FOV: 45 degrees
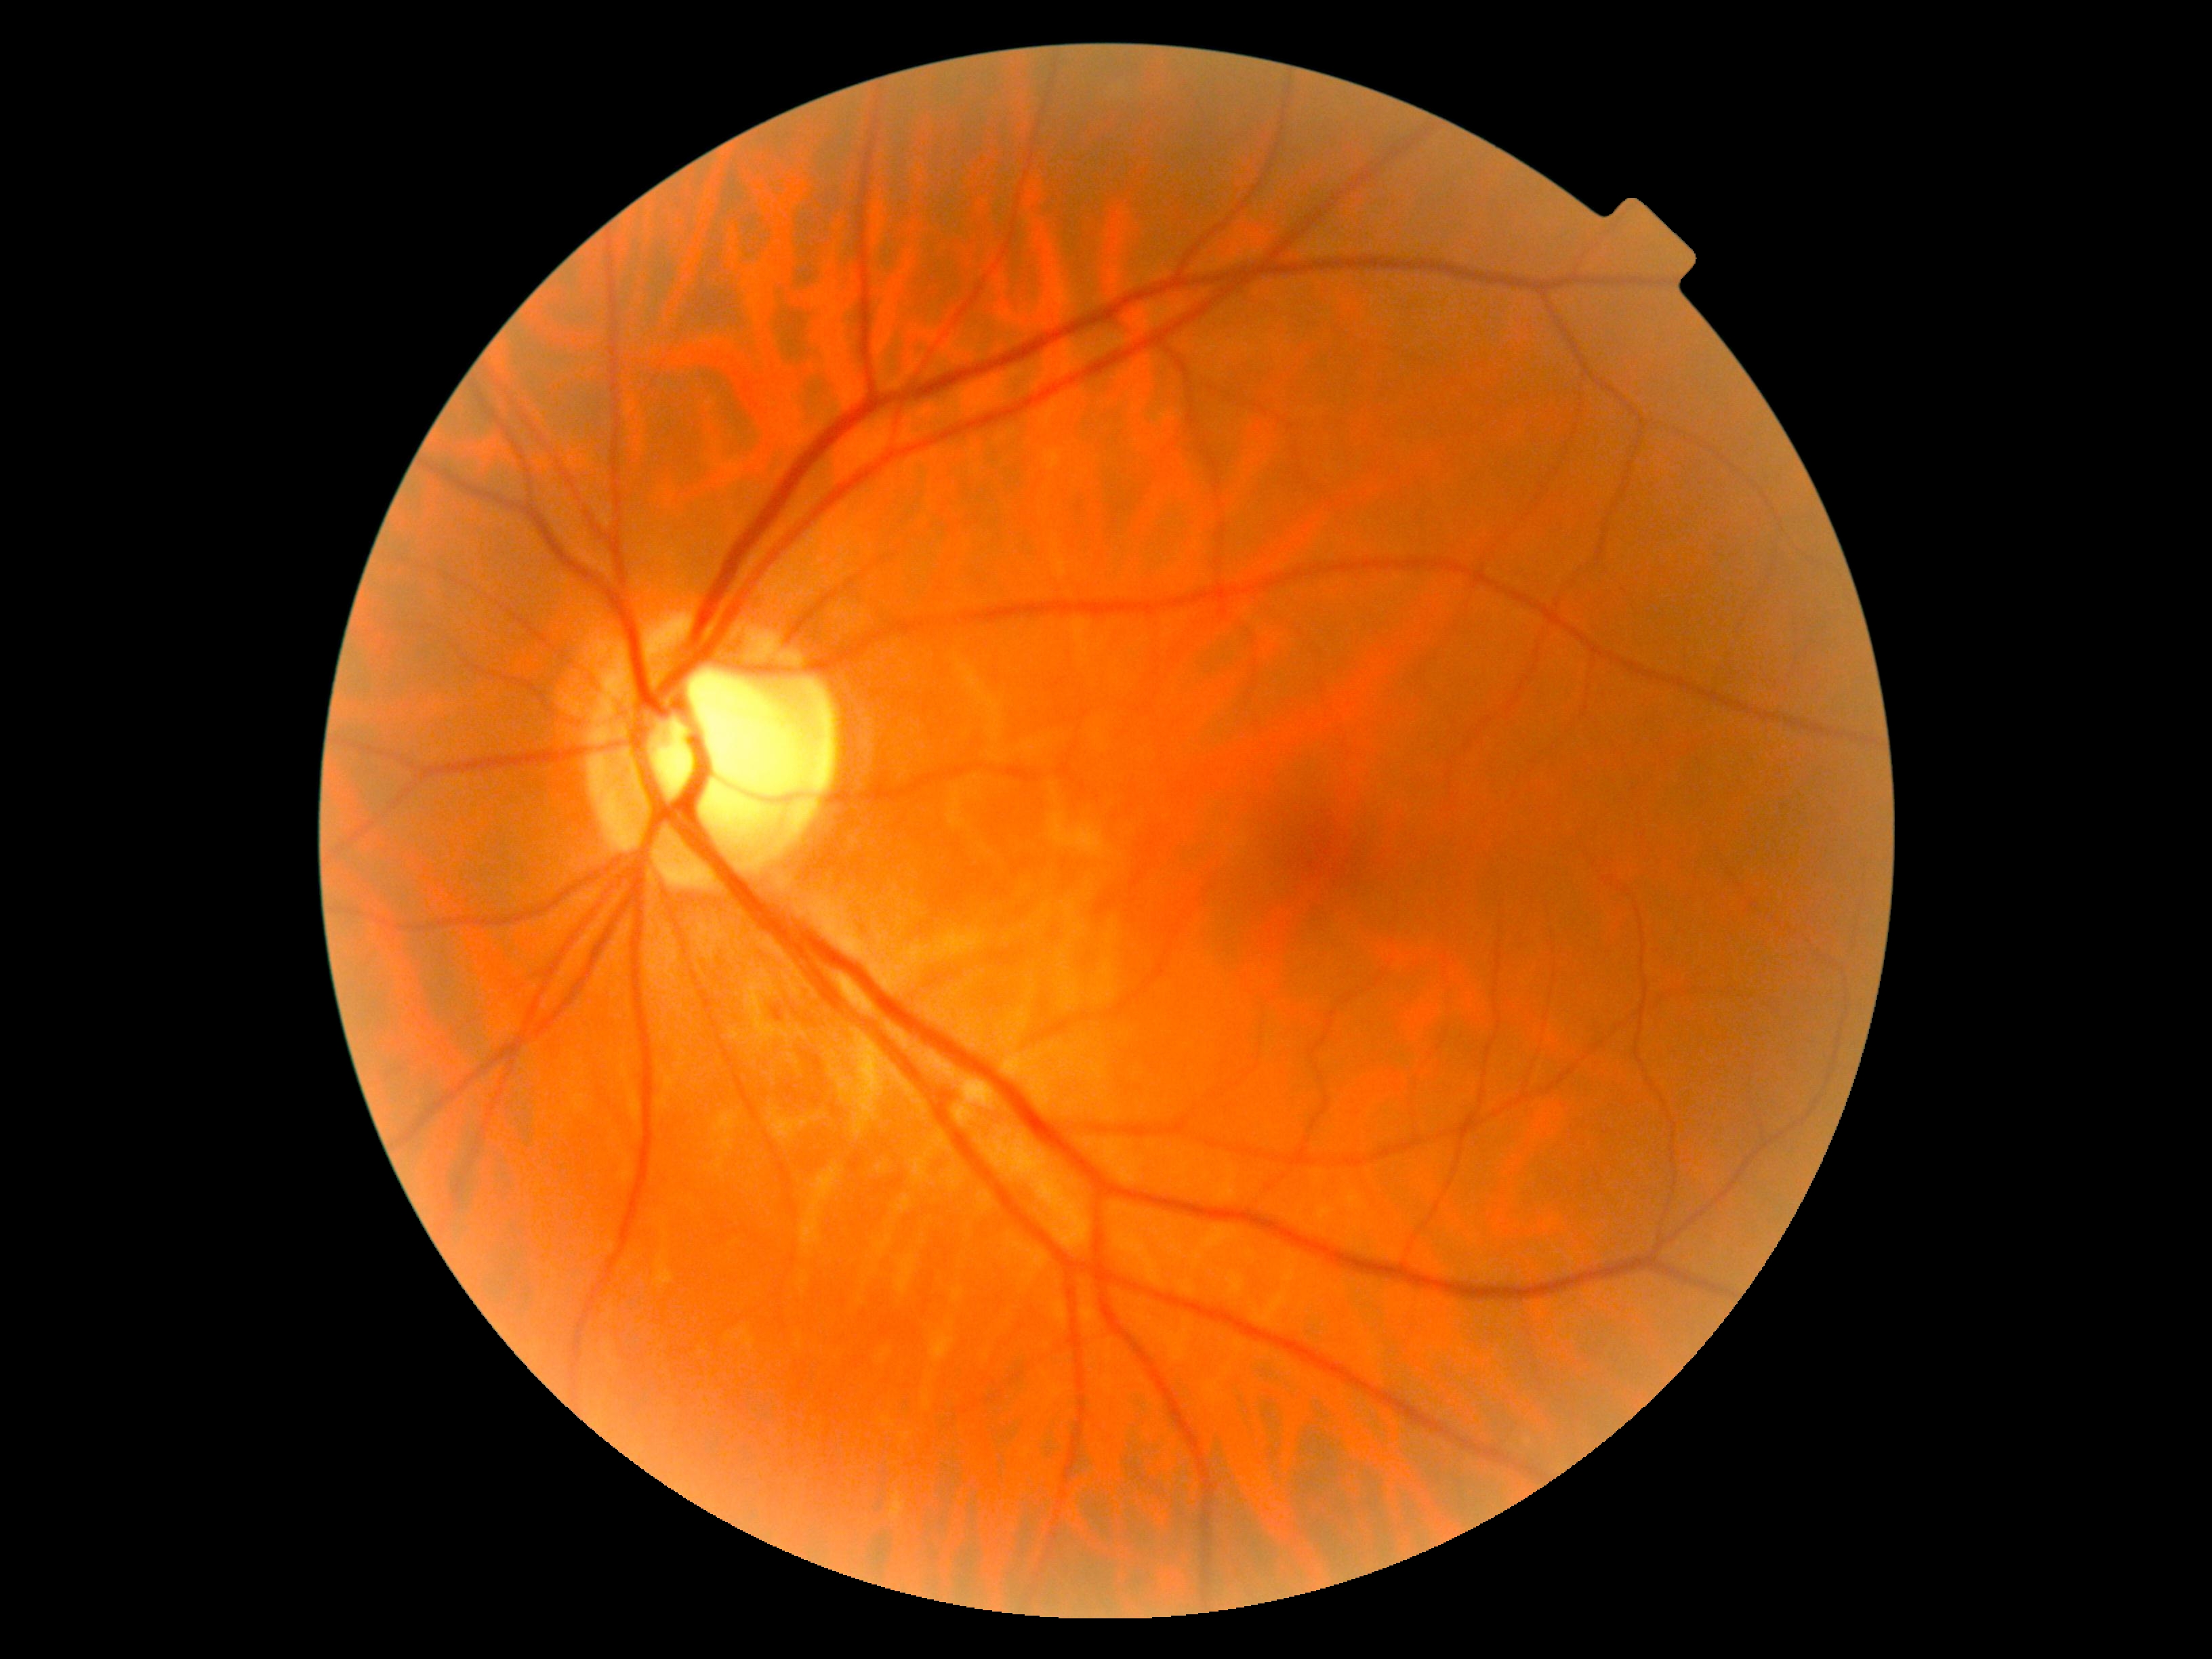

DR stage is grade 0 (no apparent retinopathy).